848x848, 45° field of view: 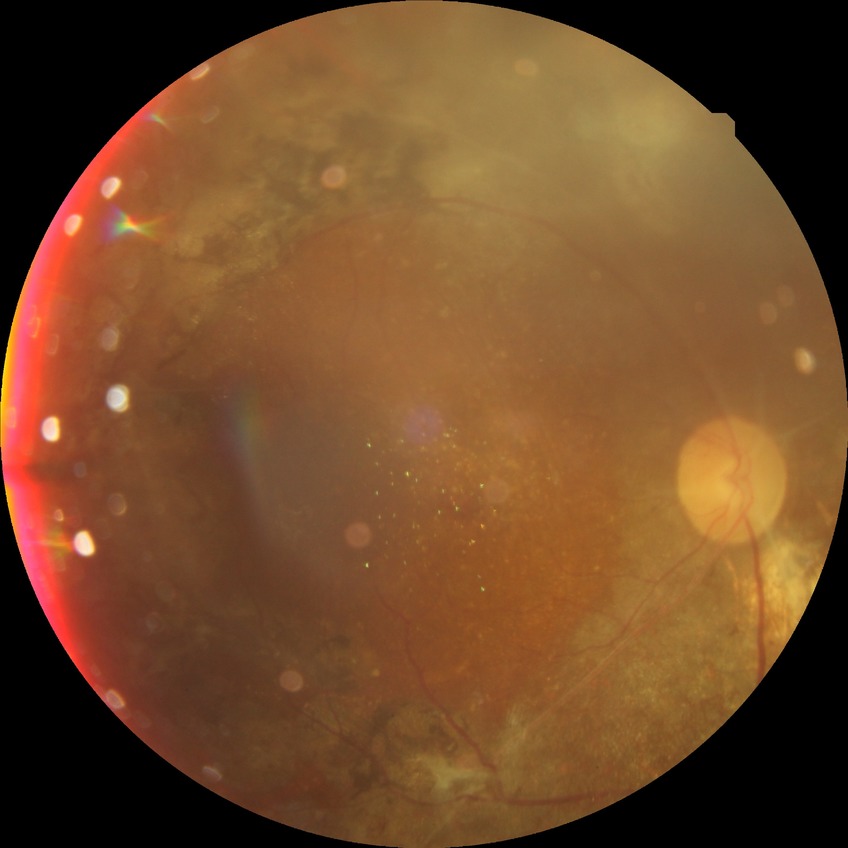

{"davis_grade": "proliferative diabetic retinopathy"}